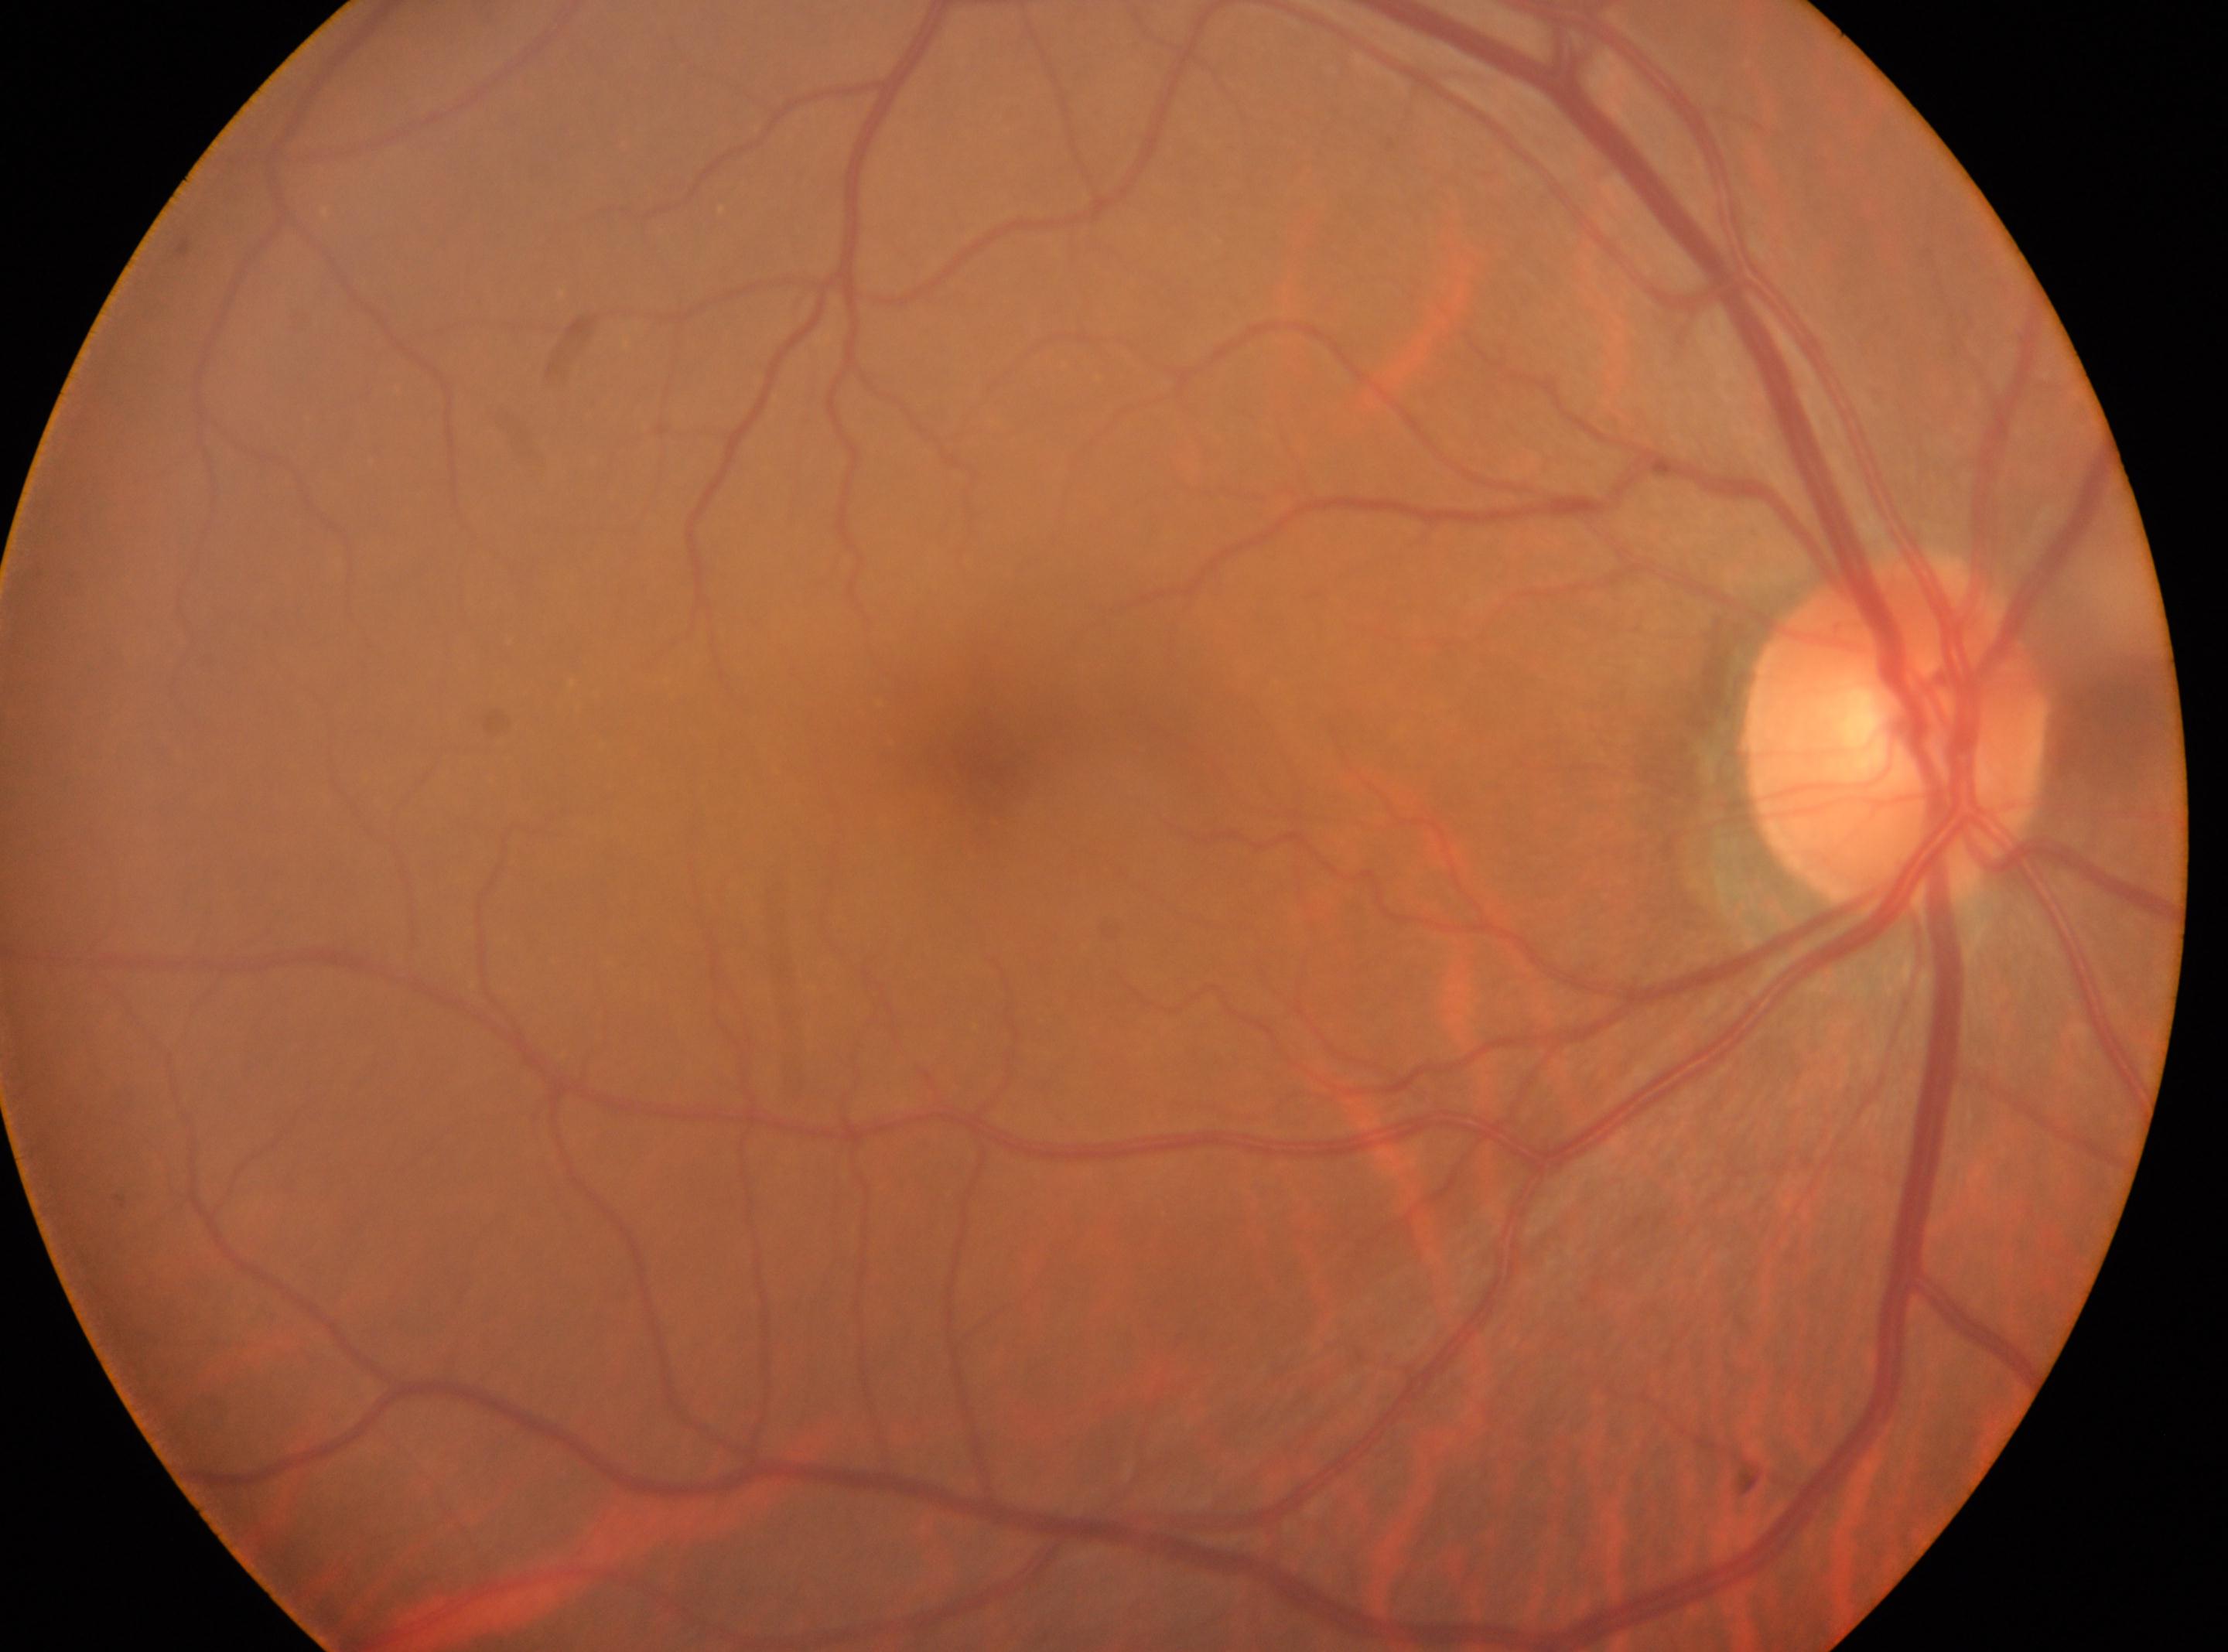 Findings:
• the fovea — 982, 744
• disc center — 1897, 729
• DR grade — no apparent retinopathy (0)
• eye — OD